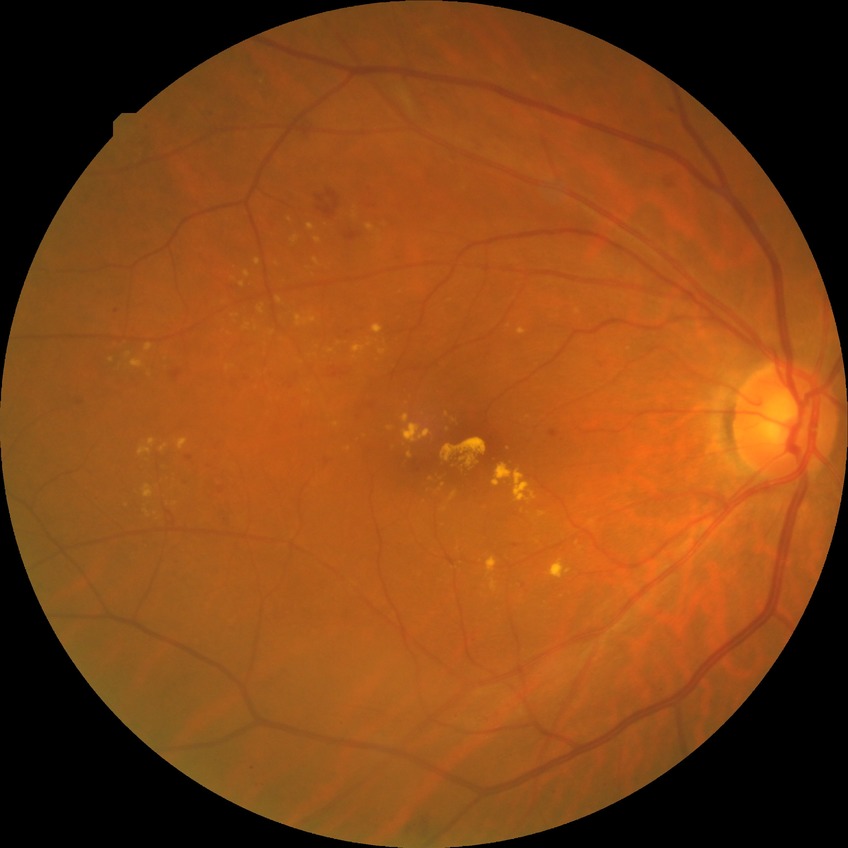 DR grade=SDR; DR class=non-proliferative diabetic retinopathy.